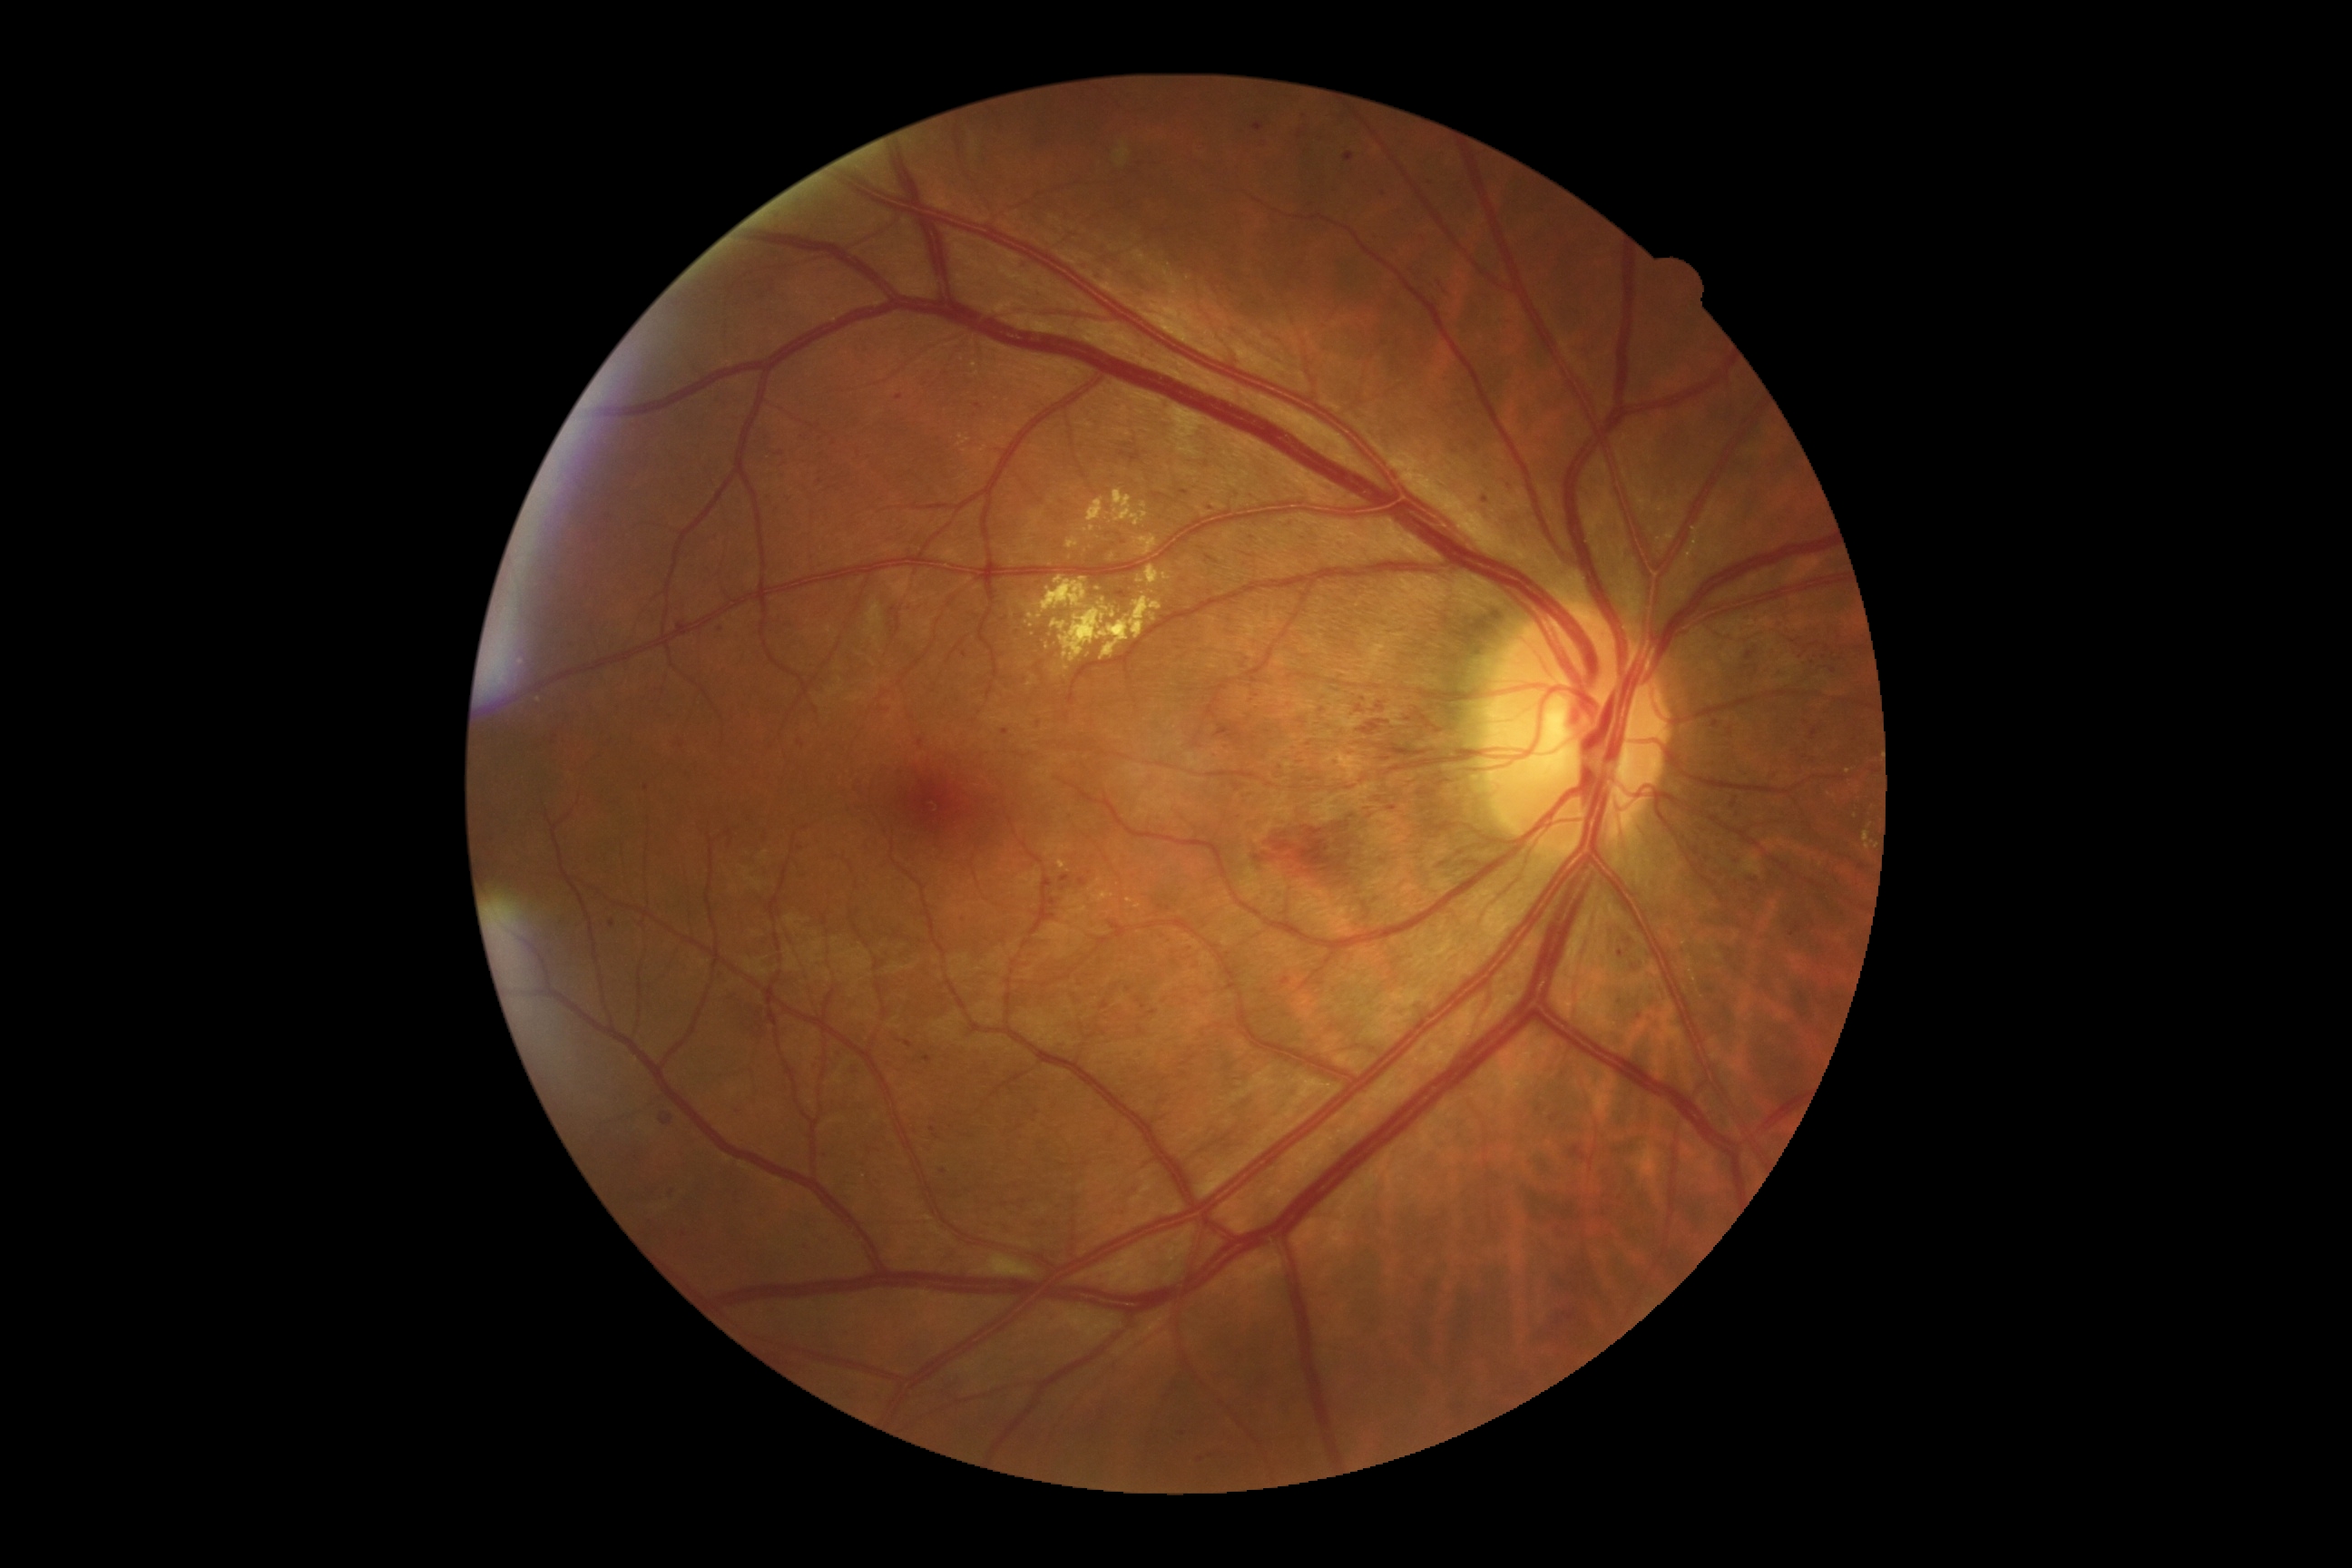 partial: true
dr_grade: 3
dr_grade_name: severe NPDR
lesions:
  he:
    - x1=1614, y1=948, x2=1627, y2=959
    - x1=1393, y1=244, x2=1406, y2=257
    - x1=1331, y1=190, x2=1340, y2=193
    - x1=1761, y1=769, x2=1779, y2=783
    - x1=716, y1=625, x2=725, y2=632
    - x1=1317, y1=177, x2=1328, y2=188
    - x1=1239, y1=676, x2=1264, y2=703
    - x1=676, y1=616, x2=694, y2=638
    - x1=1378, y1=190, x2=1386, y2=199
    - x1=1043, y1=877, x2=1054, y2=896
    - x1=1048, y1=899, x2=1057, y2=906
    - x1=1095, y1=273, x2=1106, y2=282
    - x1=1431, y1=295, x2=1440, y2=306
  he_small_approx:
    - 672, 1193
    - 1142, 1031
    - 801, 744
    - 1264, 992
    - 1004, 1206